512 x 512 pixels:
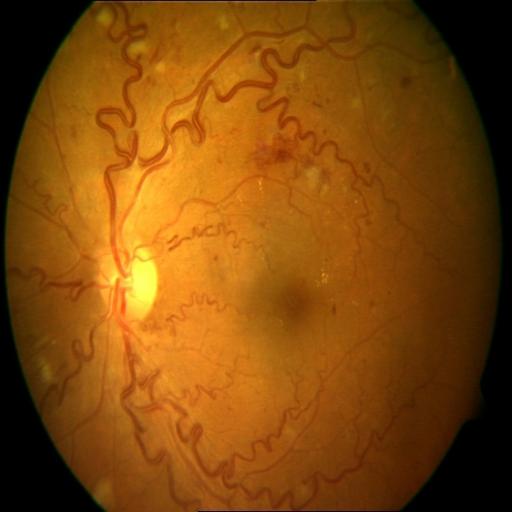
Abnormalities: tortuous vessels.